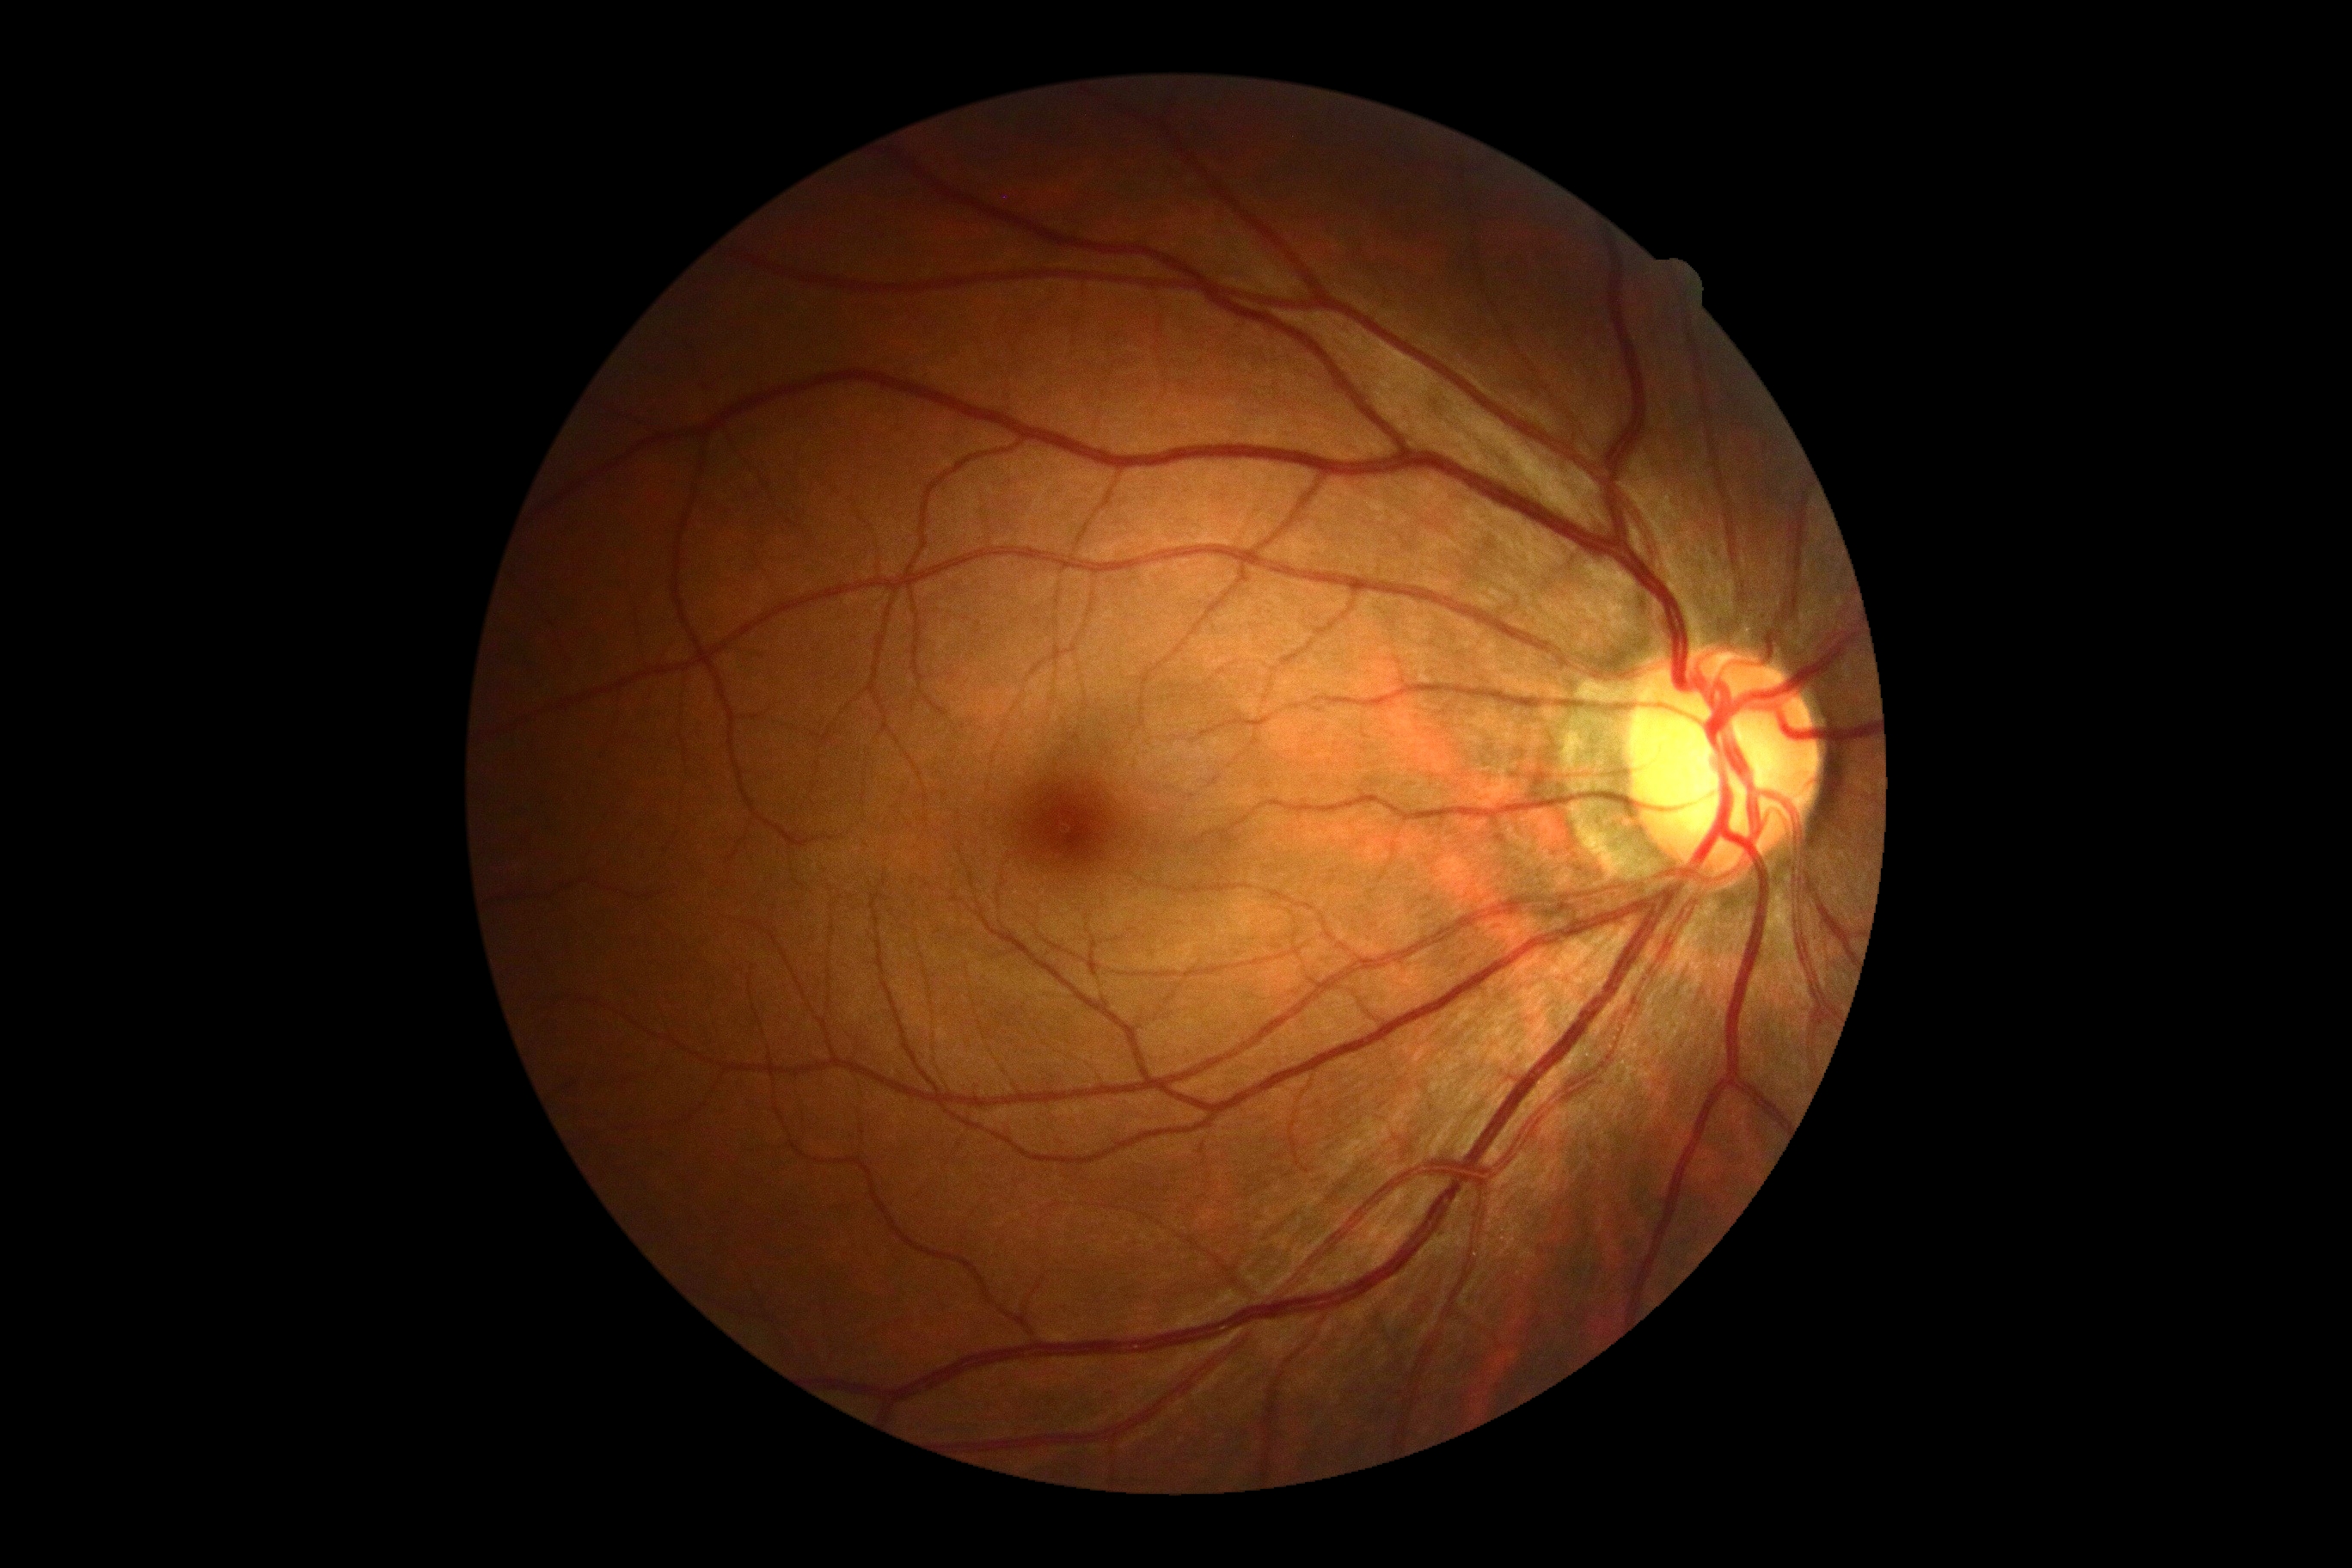
dr_grade: no apparent diabetic retinopathy (grade 0)